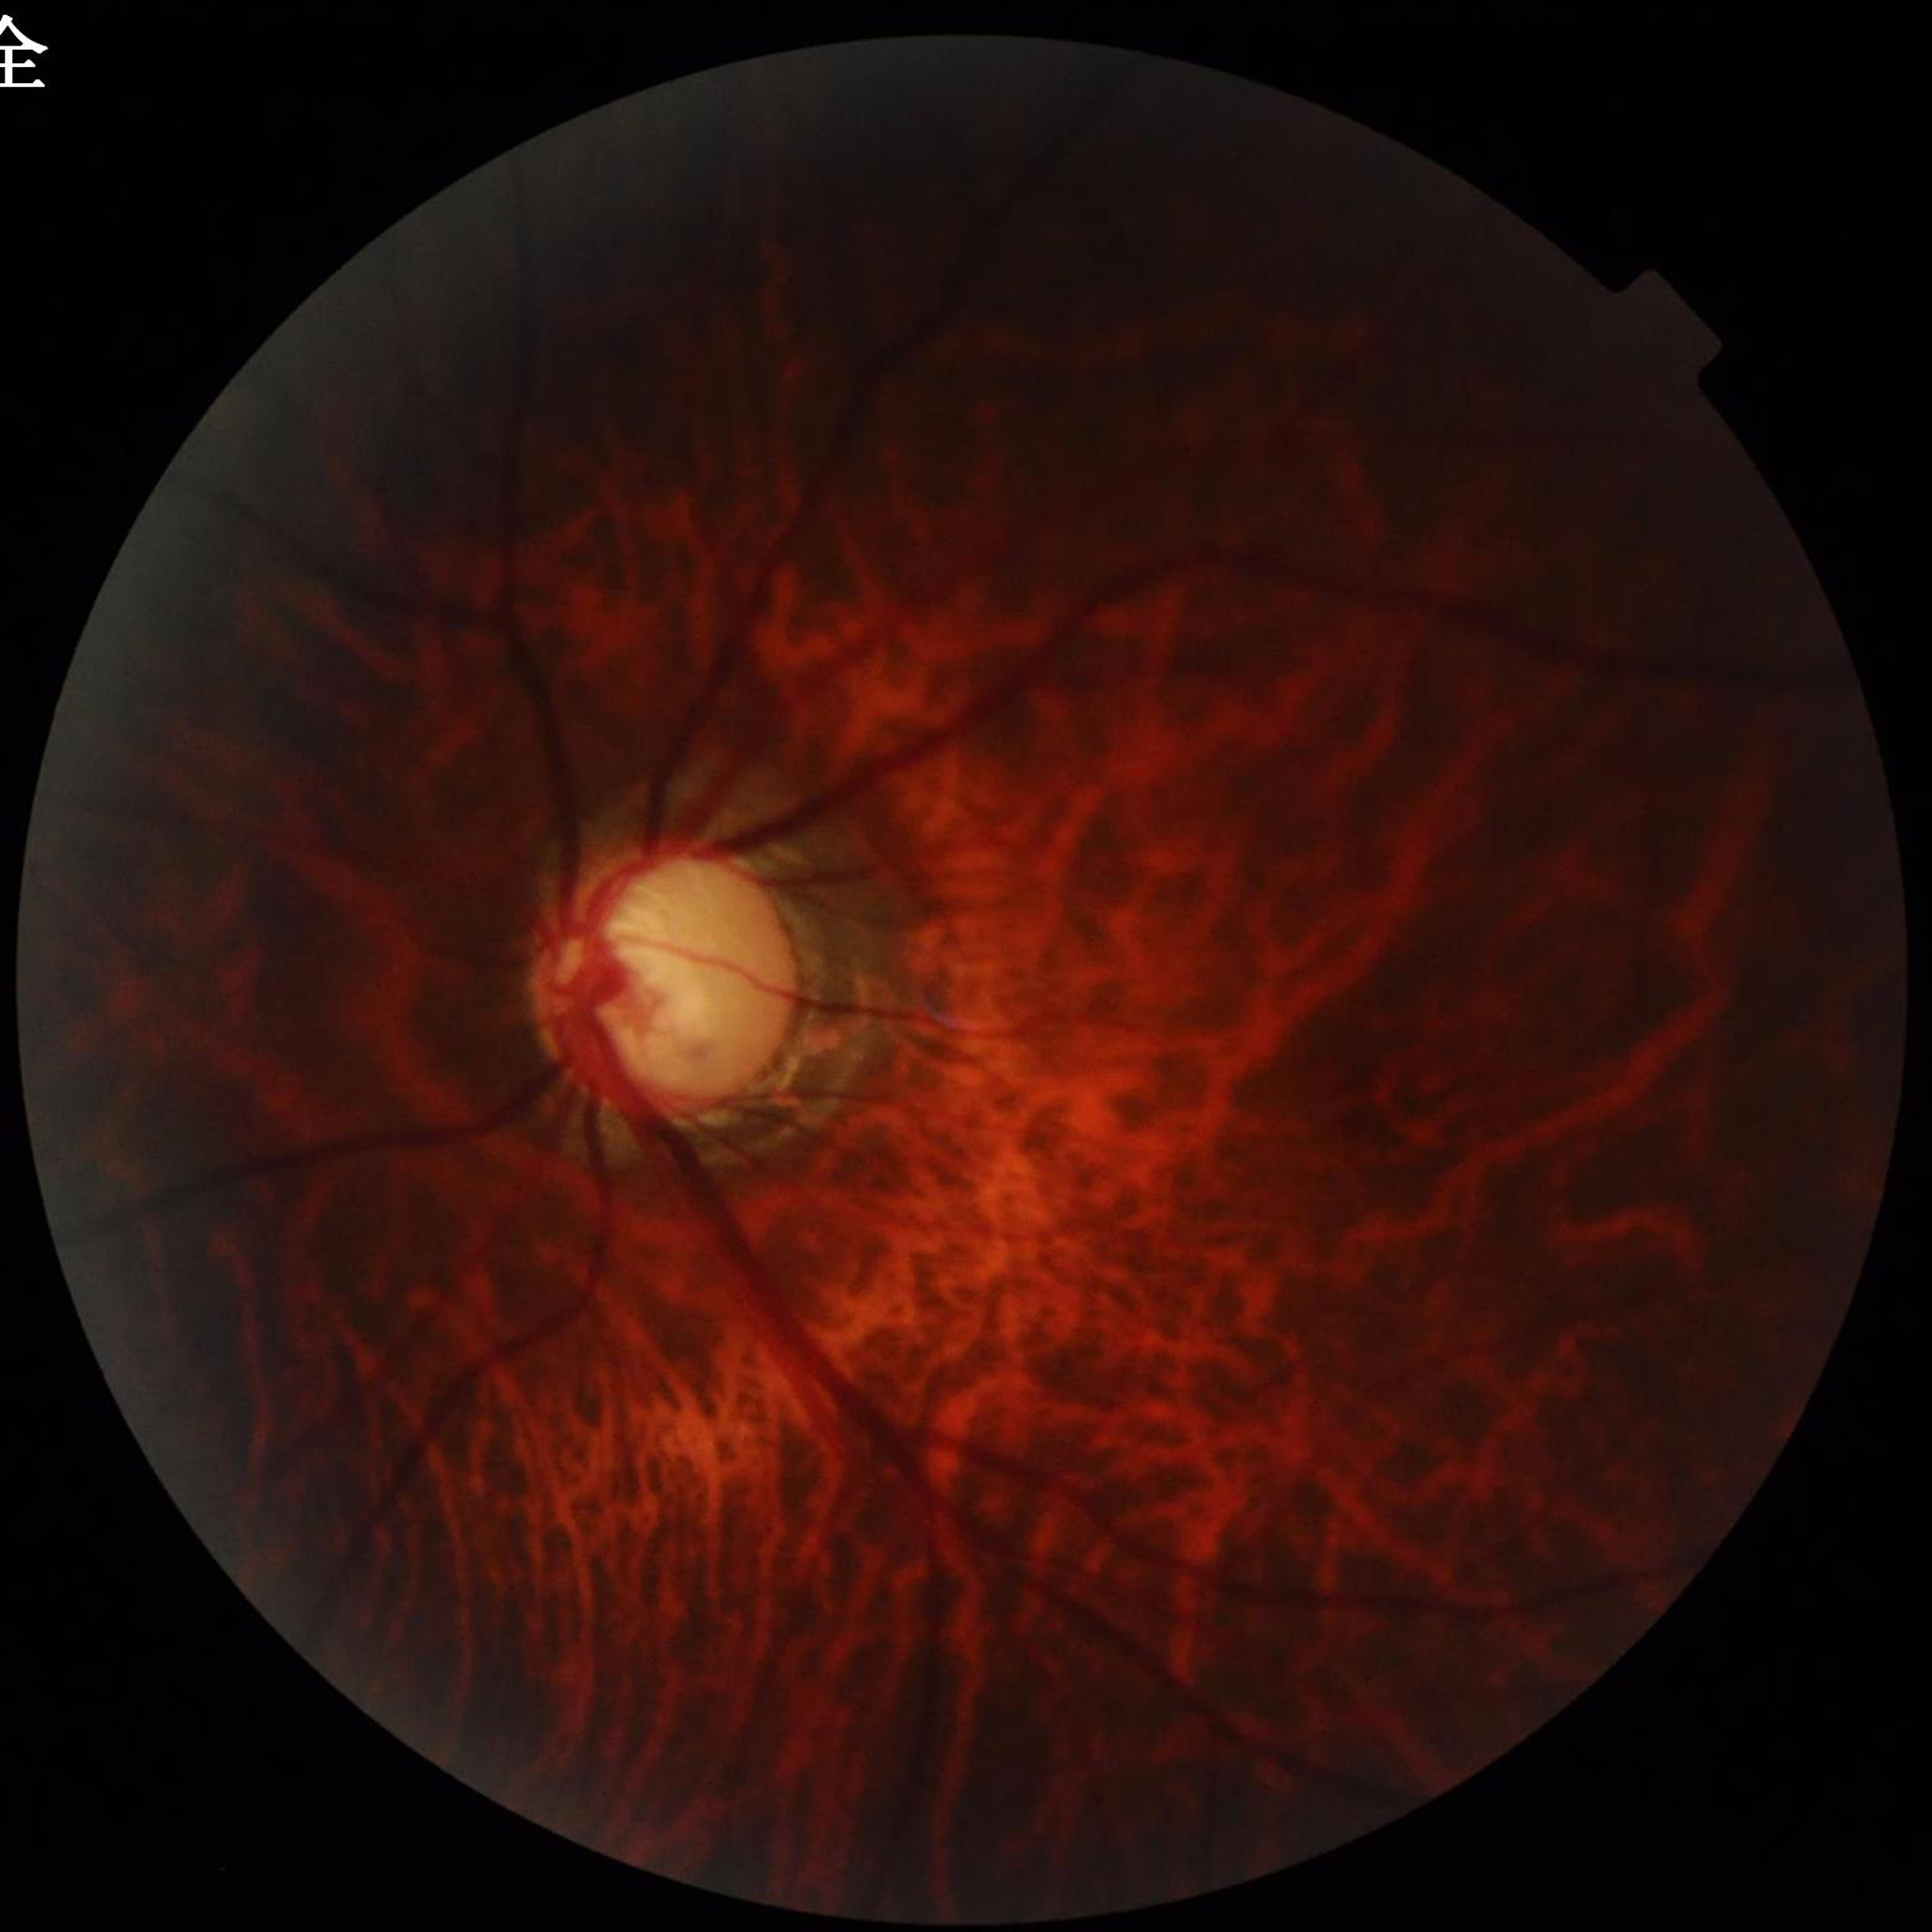 Photo quality: reduced — blur, illumination/color distortion. Fundus image of an eye with glaucoma.